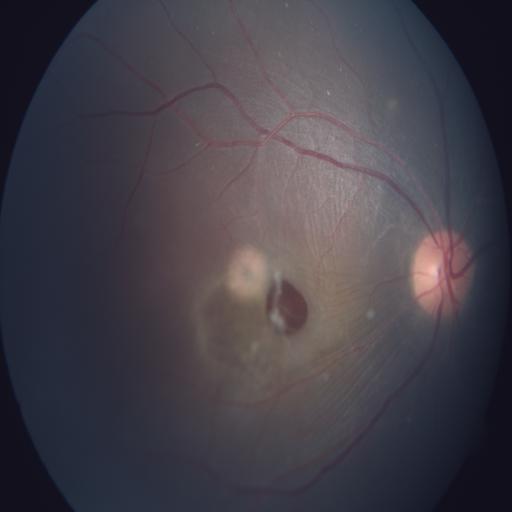

Findings consistent with retinal detachment.